848x848; modified Davis grading; NIDEK AFC-230; FOV: 45 degrees; posterior pole color fundus photograph — 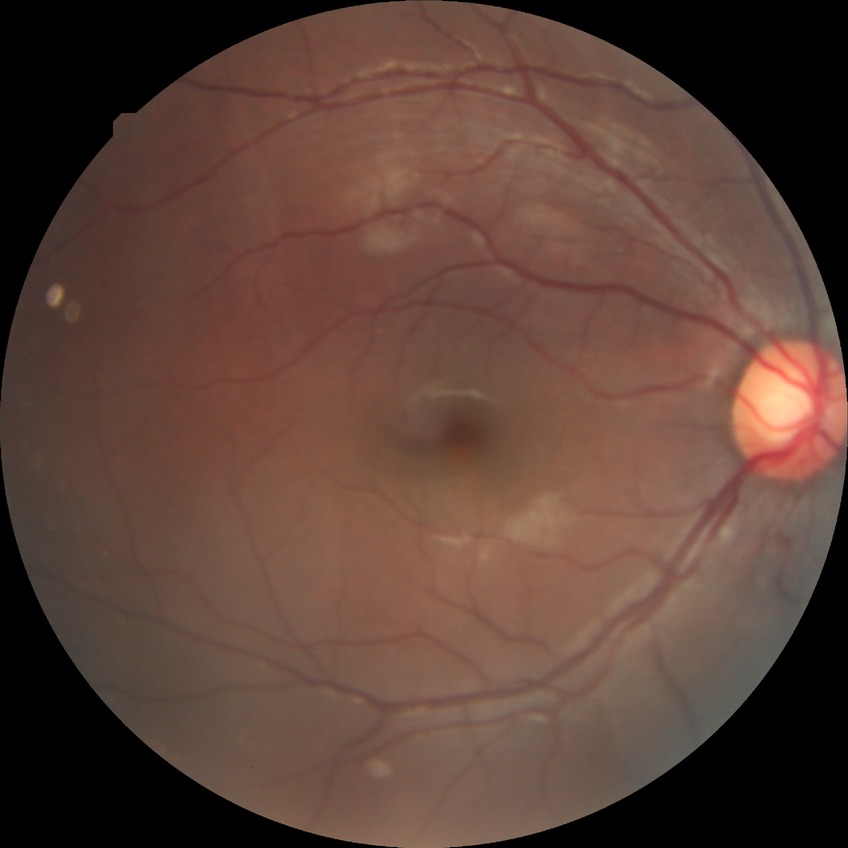
Diabetic retinopathy (DR) is NDR (no diabetic retinopathy).